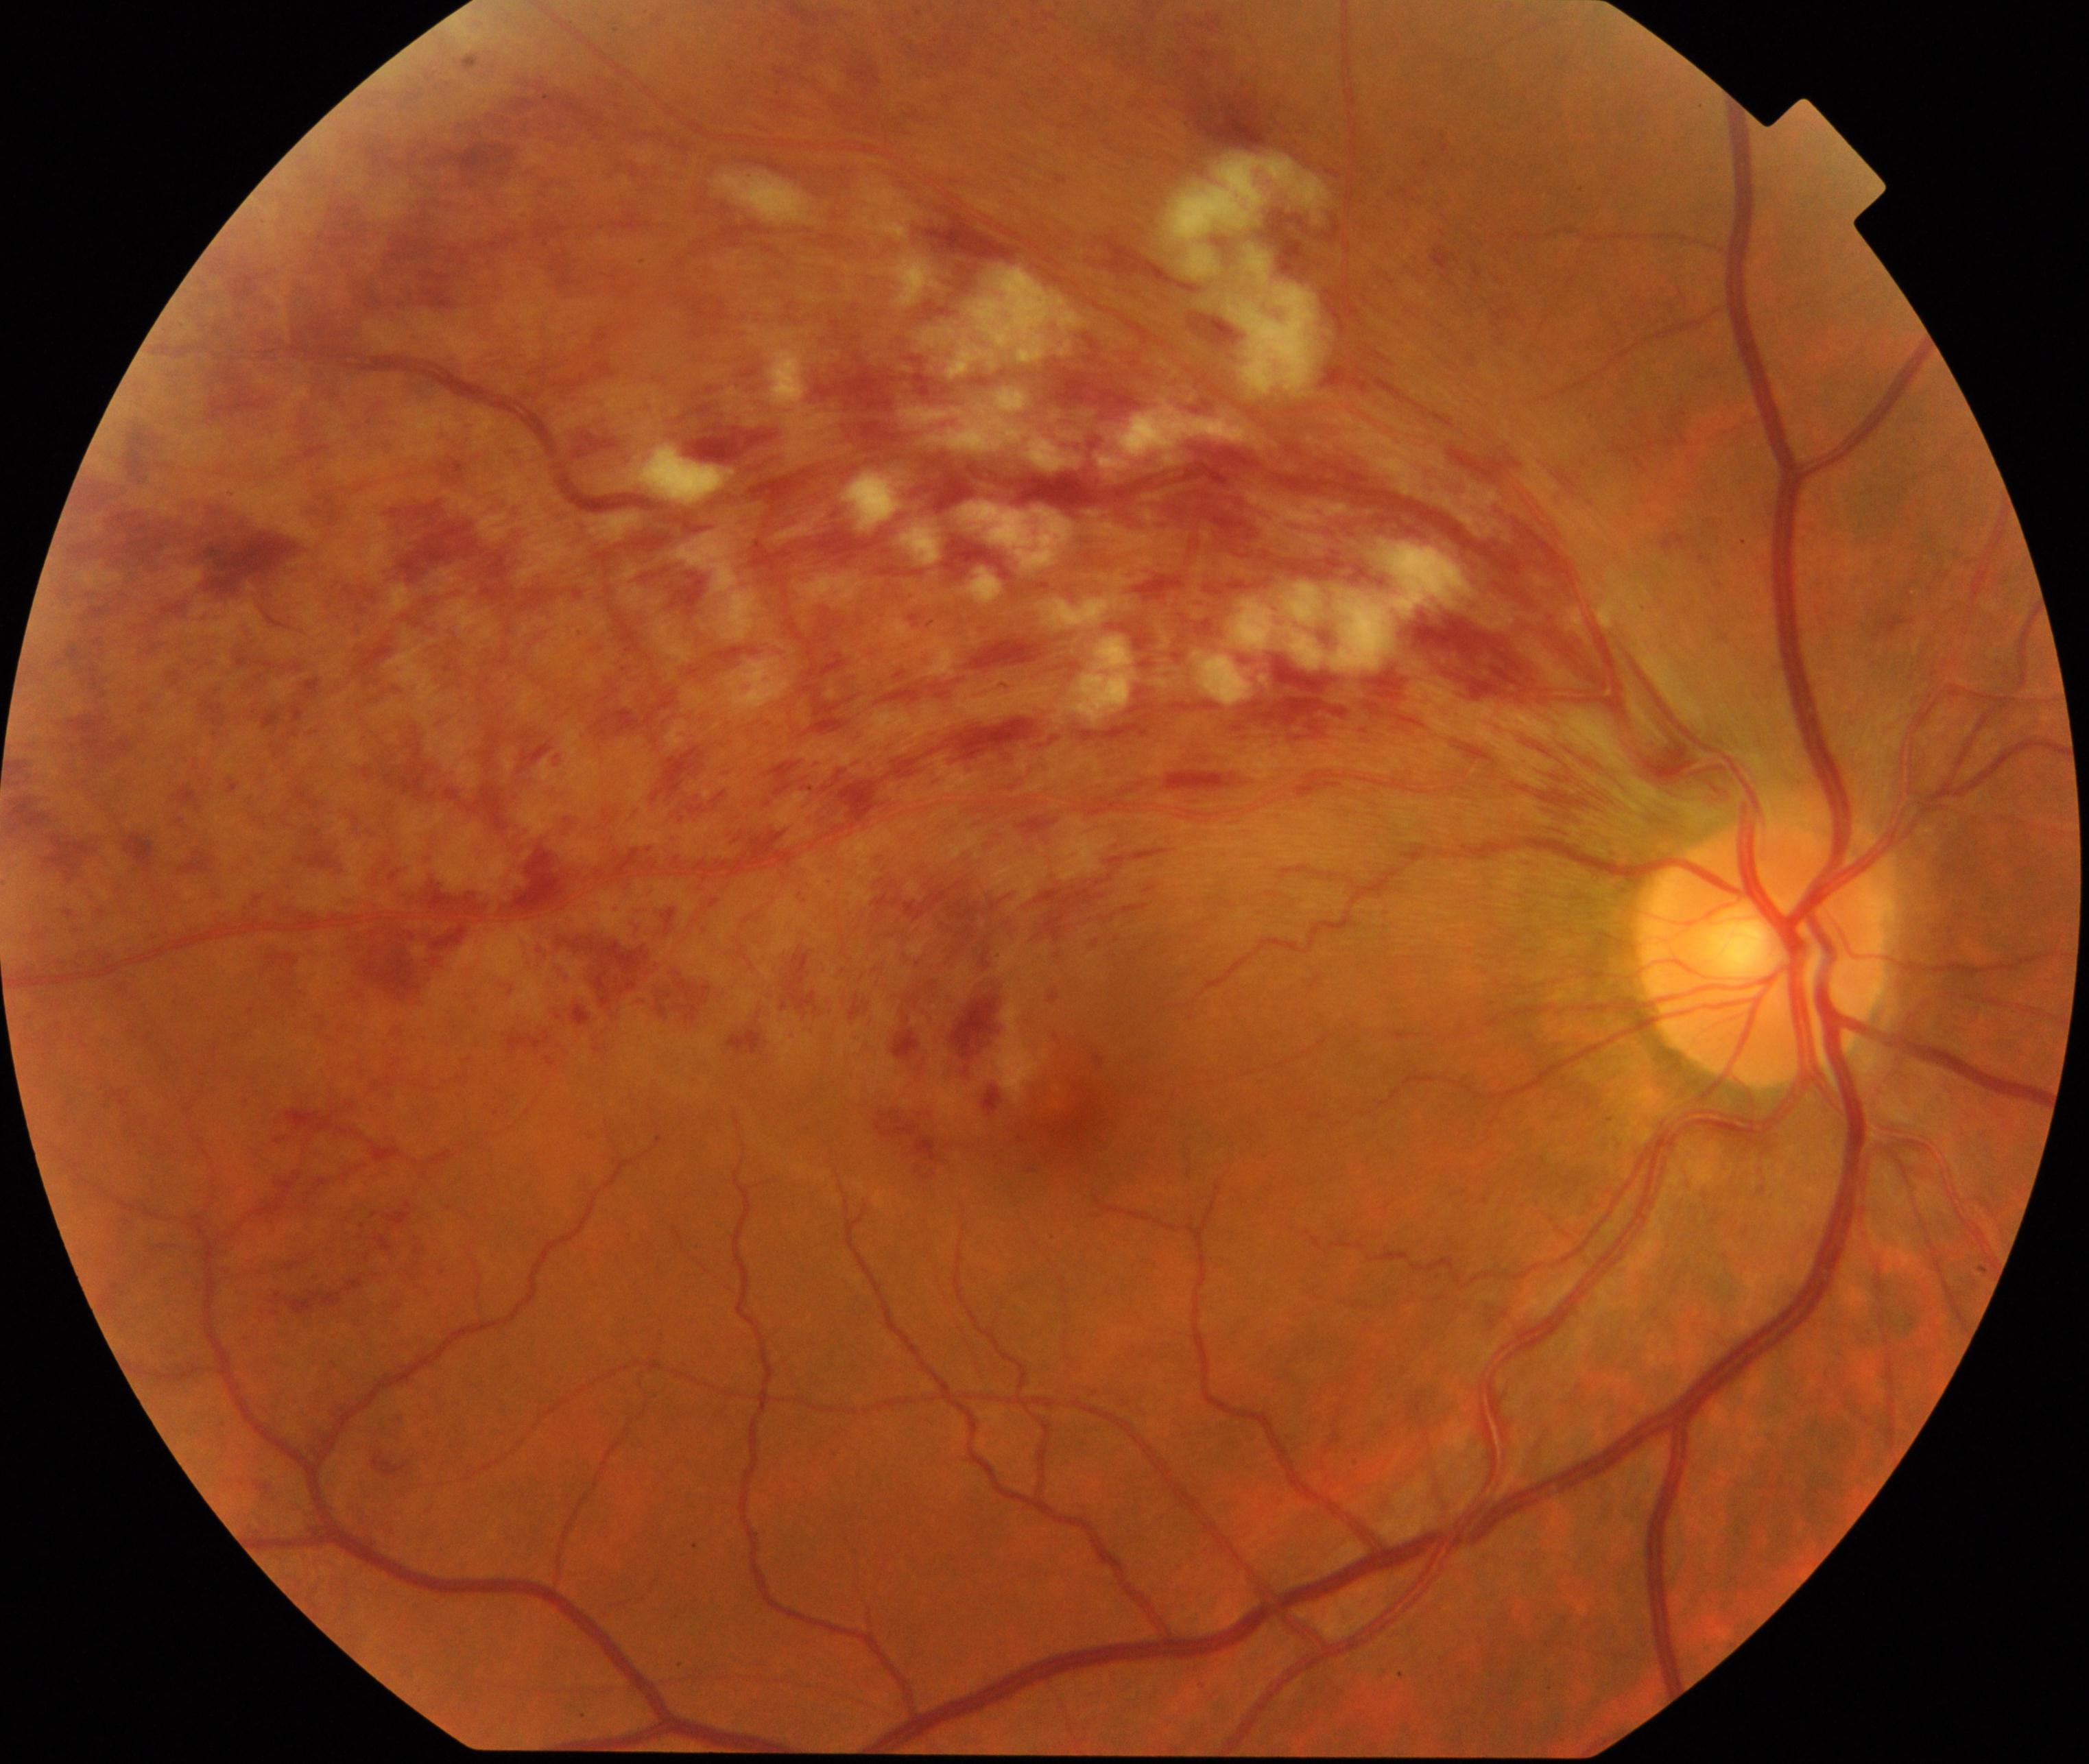

Retinal fundus photograph demonstrating branch retinal vein occlusion.